Color fundus photograph; NIDEK AFC-230; modified Davis grading — 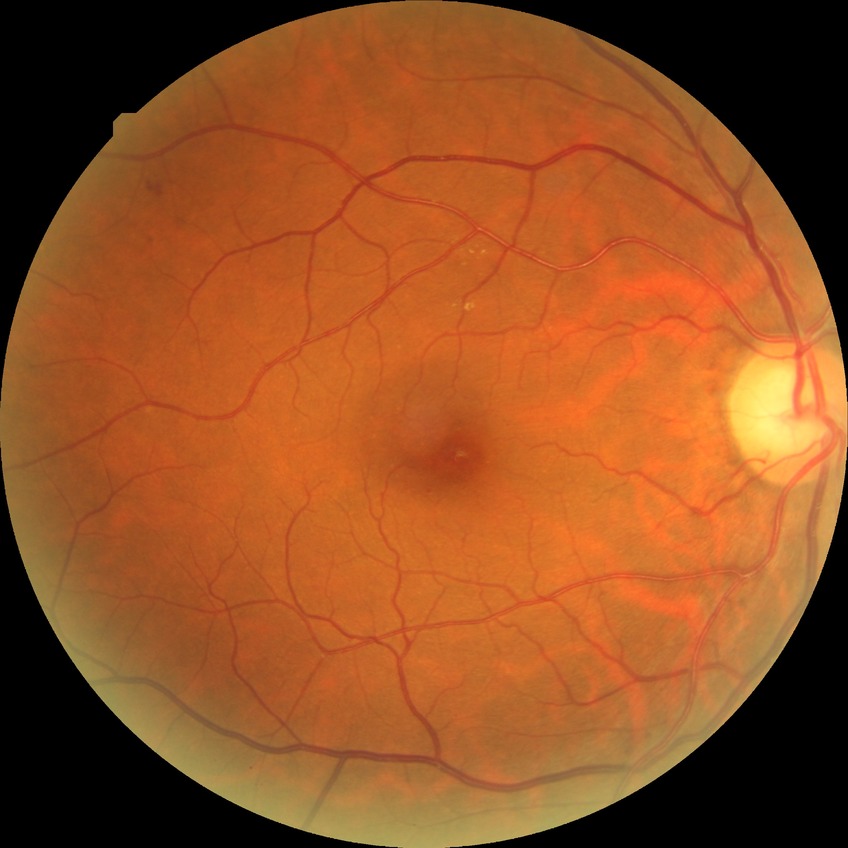
The retinopathy is classified as non-proliferative diabetic retinopathy. Diabetic retinopathy grade is simple diabetic retinopathy.